Captured after pupil dilation:
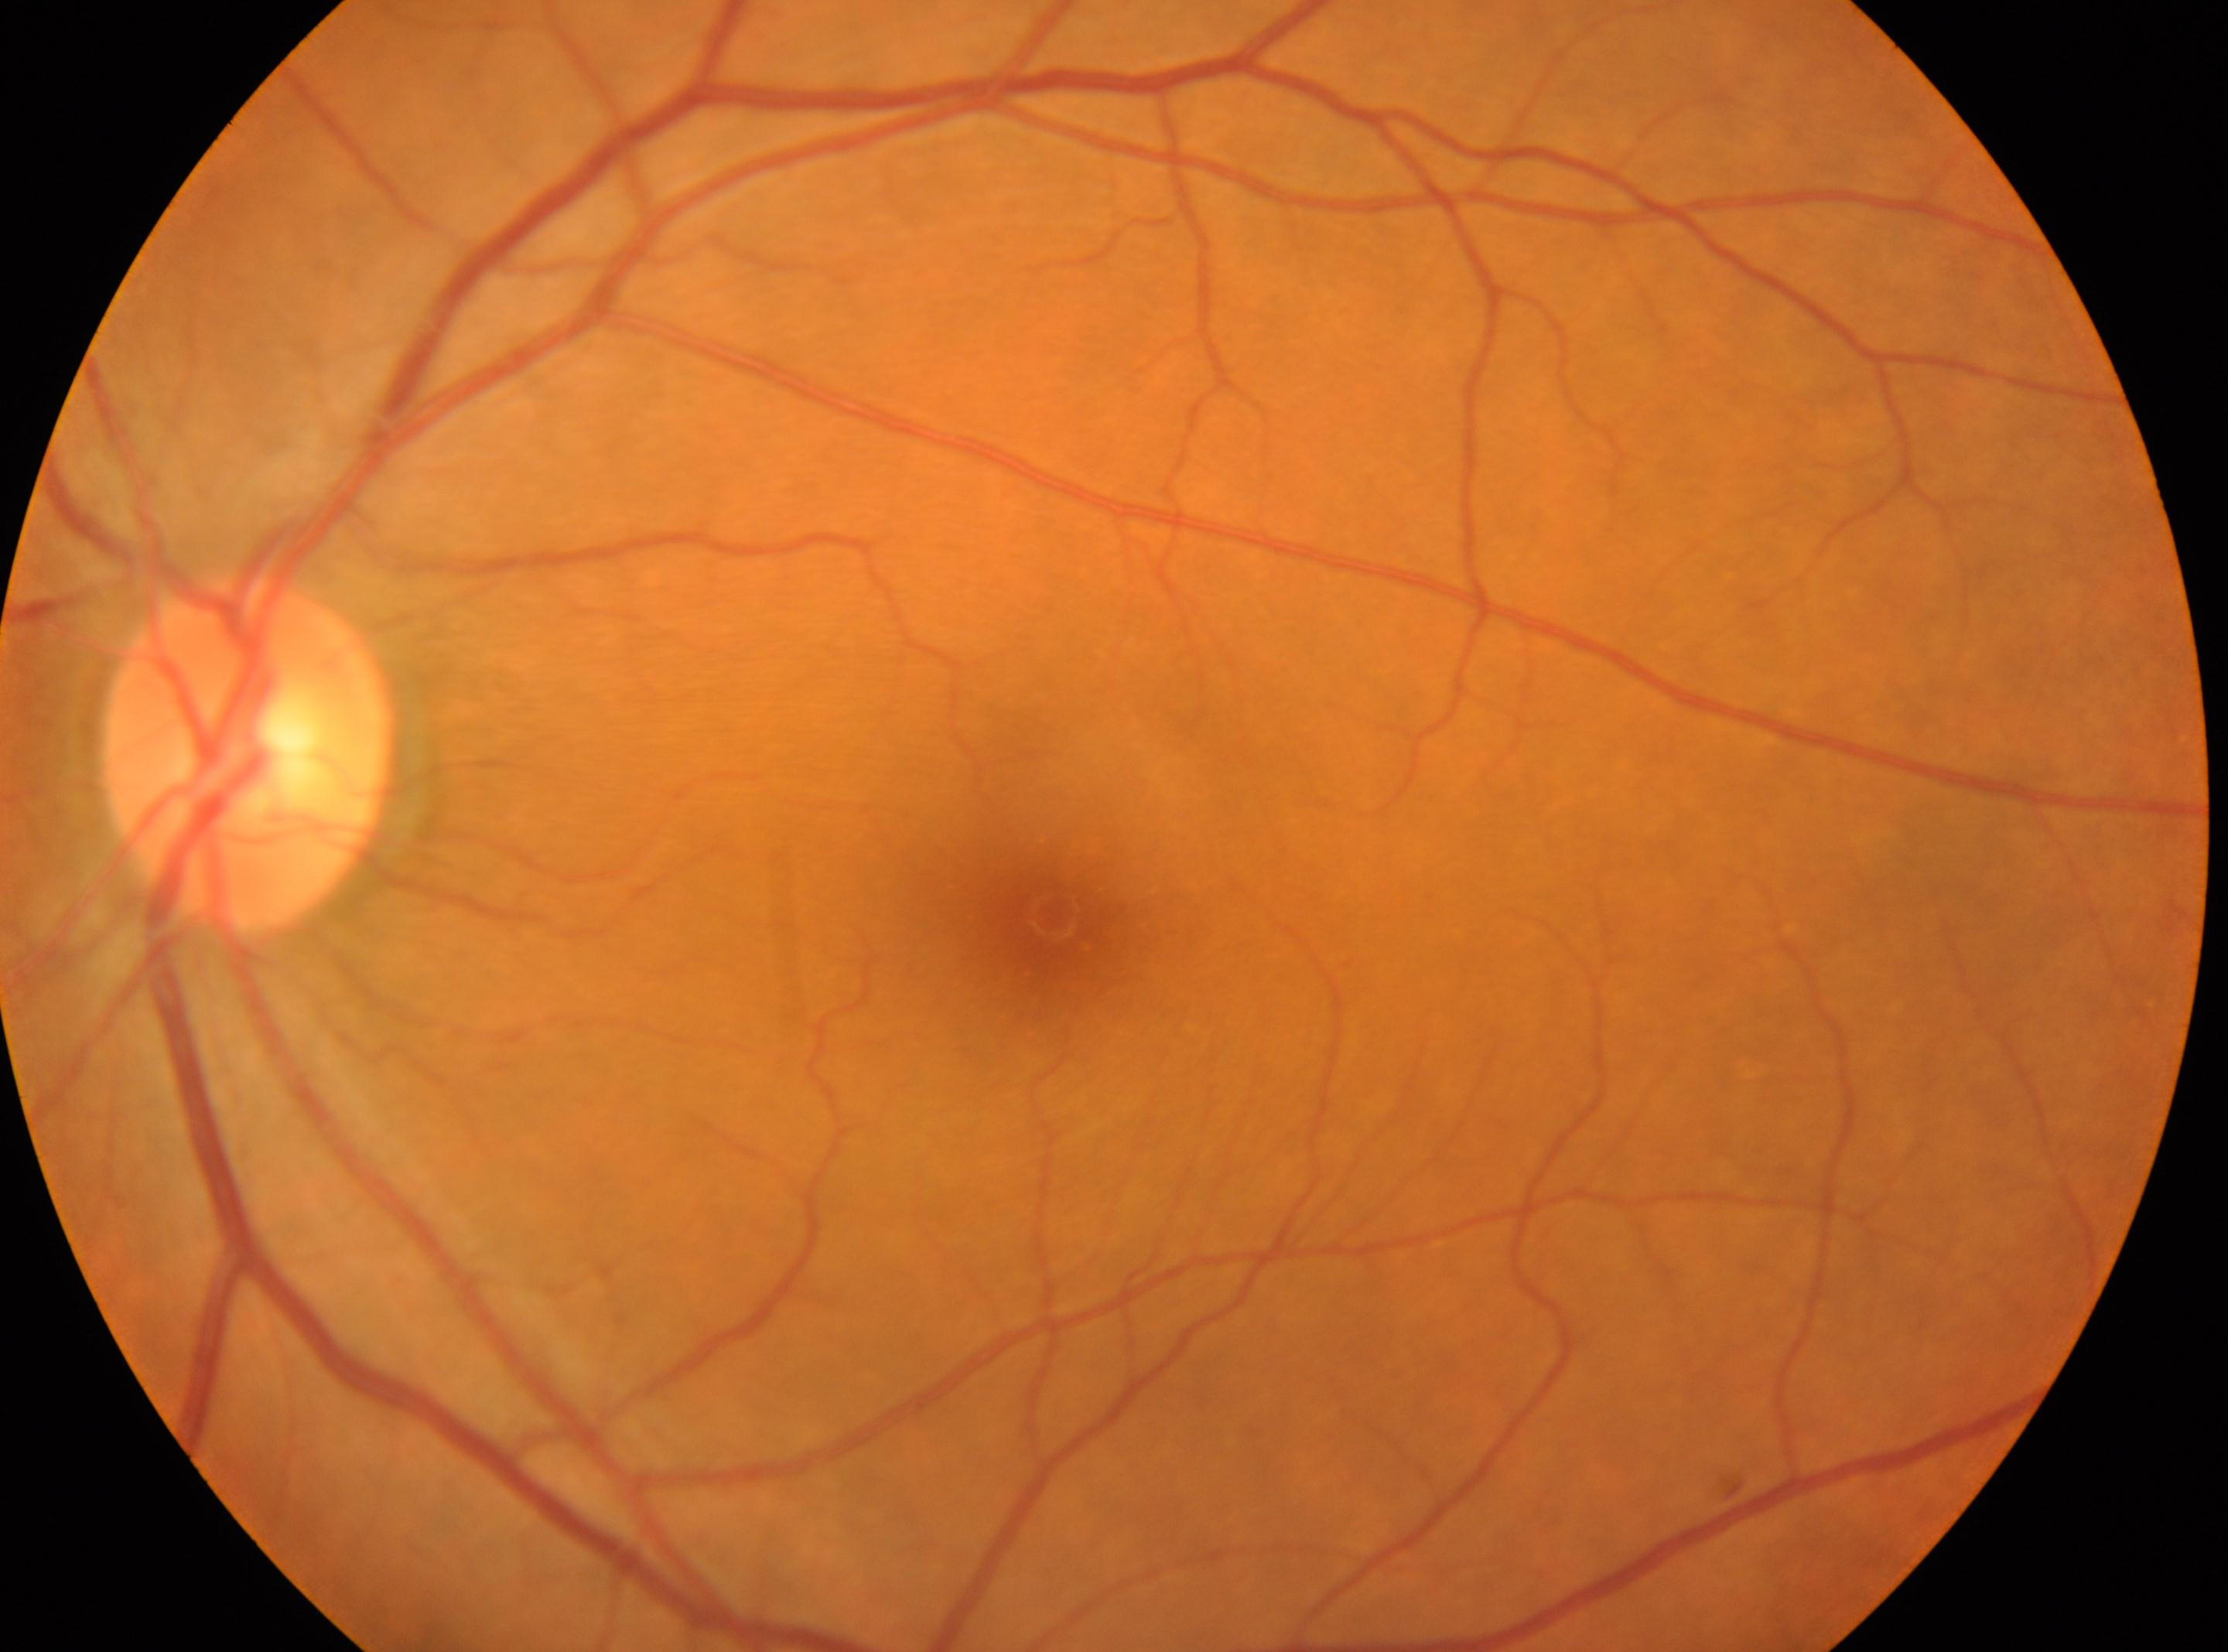 Retinopathy: grade 0 (no apparent retinopathy). Eye: oculus sinister. ONH located at x=249, y=753. The macula center is at x=1051, y=913.